Captured on a Kowa VX-10α fundus camera
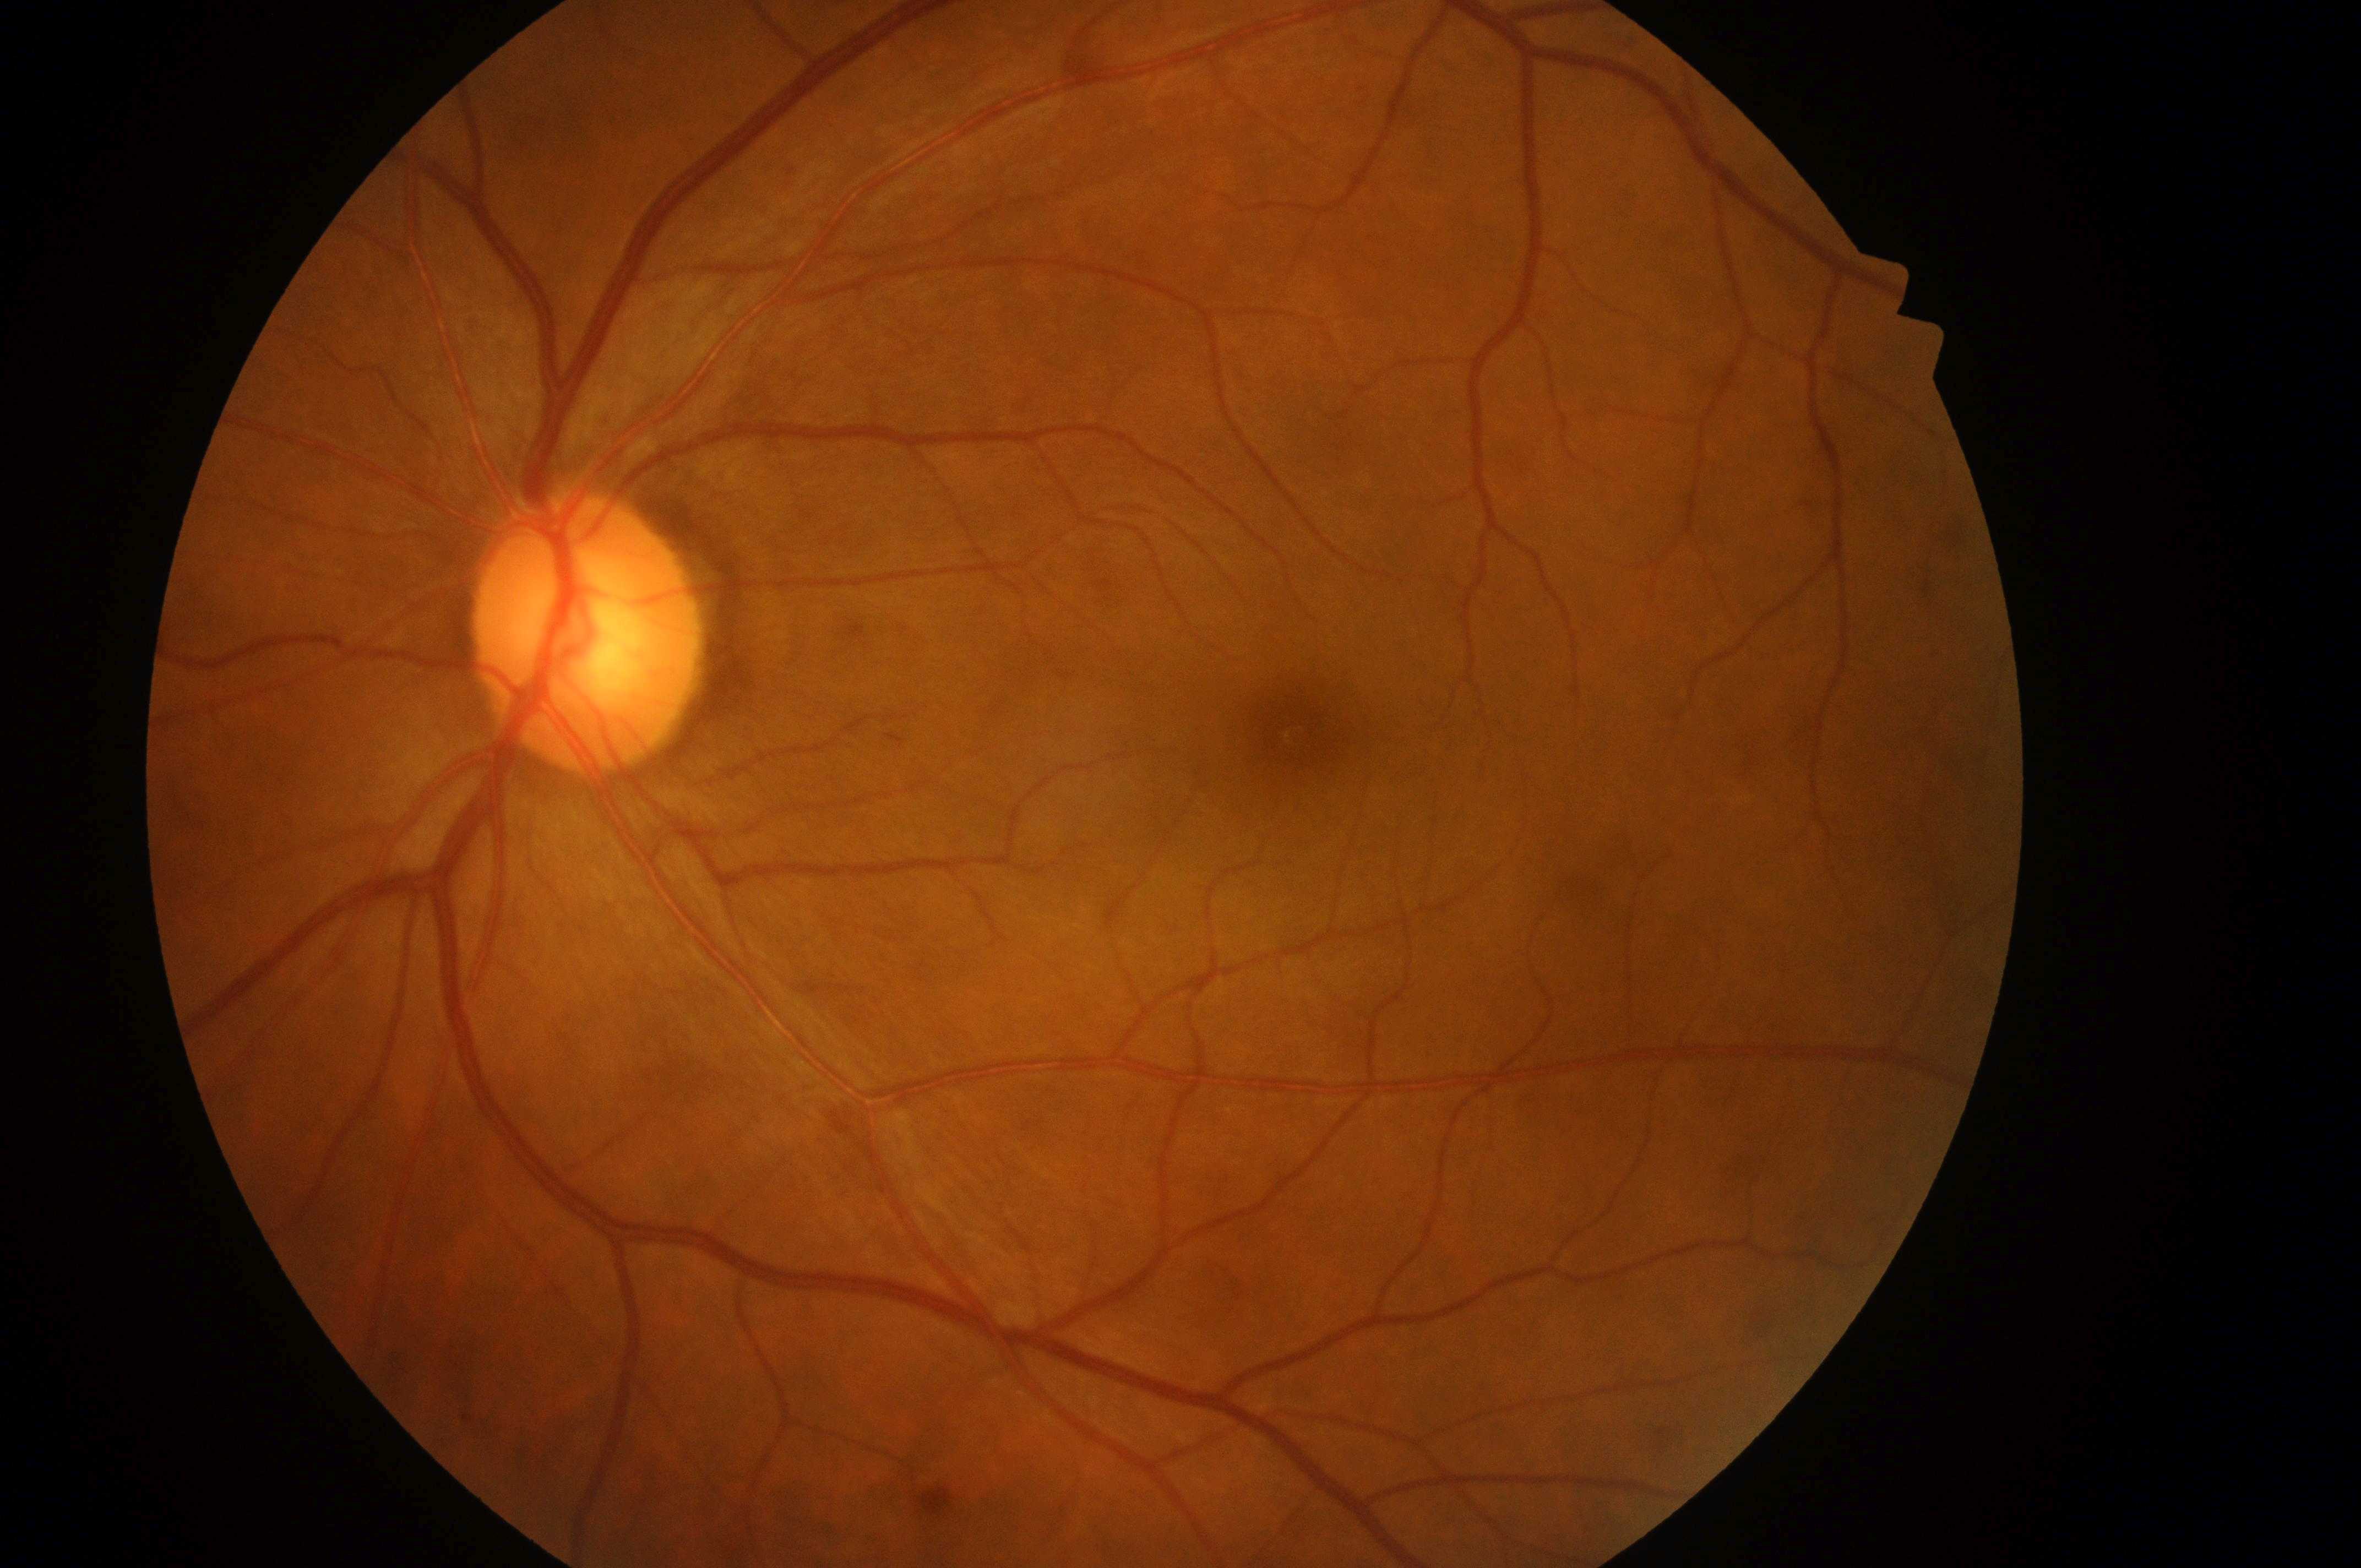
No diabetic retinopathy; no macular edema risk.
Risk of diabetic macular edema is no risk (grade 0).
Foveal center located at (x: 1302, y: 732).
Diabetic retinopathy severity is grade 0 (no apparent retinopathy).
Imaged eye: left.
Disc center located at (x: 585, y: 643).